Phoenix ICON, 100° FOV. Image size 1240x1240. Phoenix ICON wide-field infant fundus image:
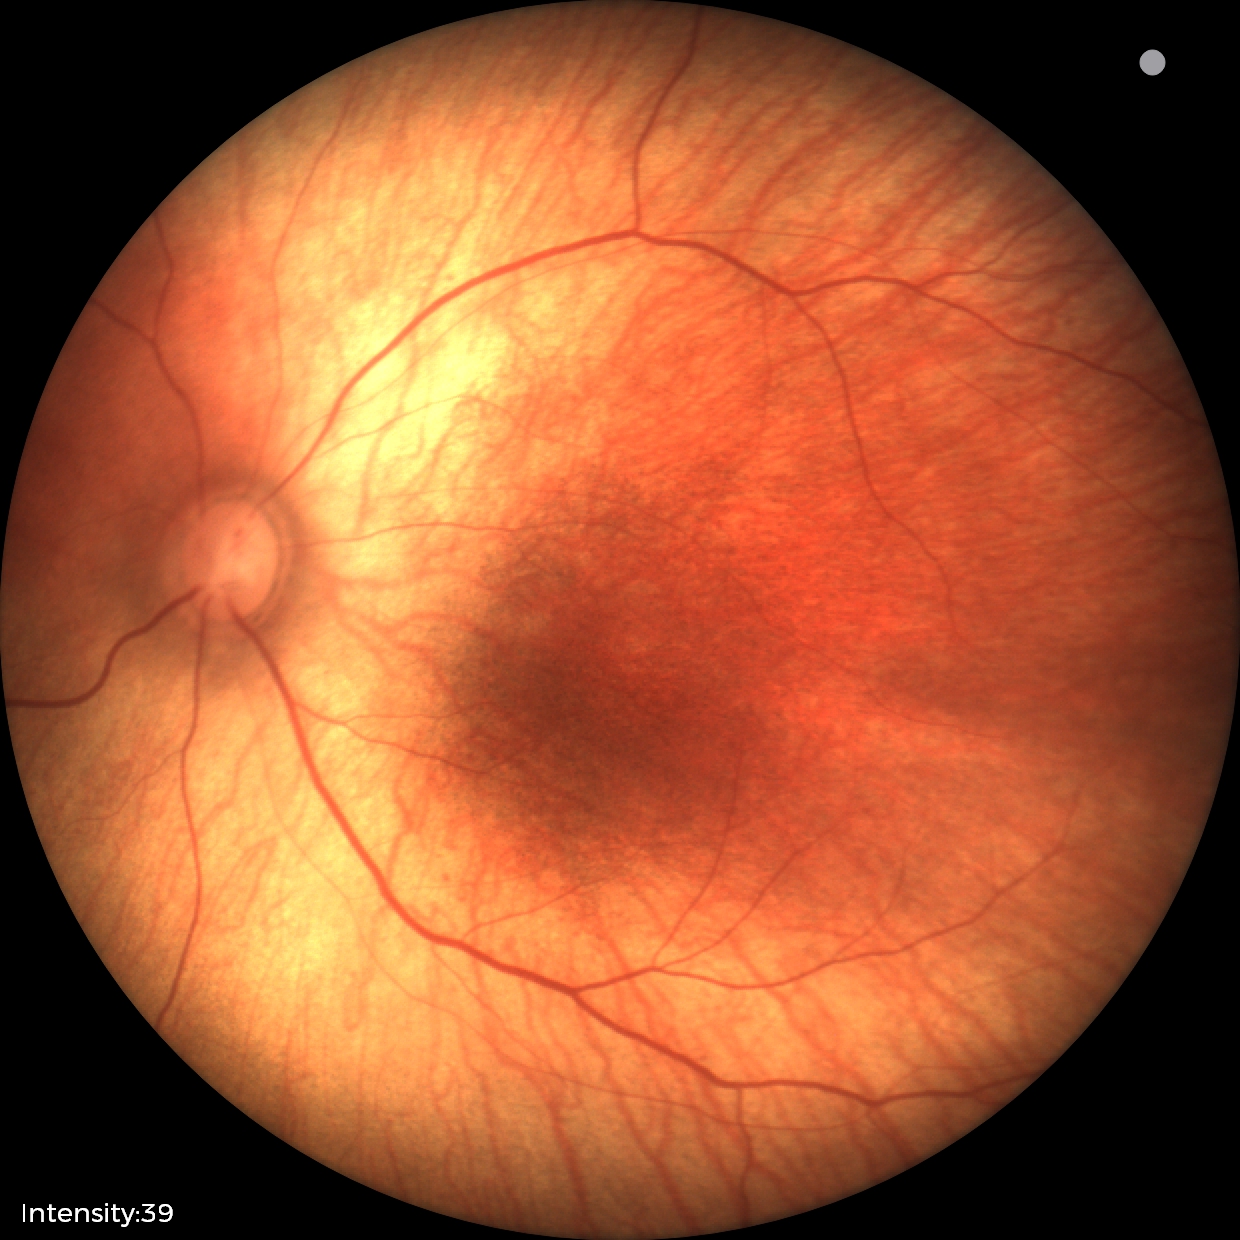 Assessment: normal retinal appearance.